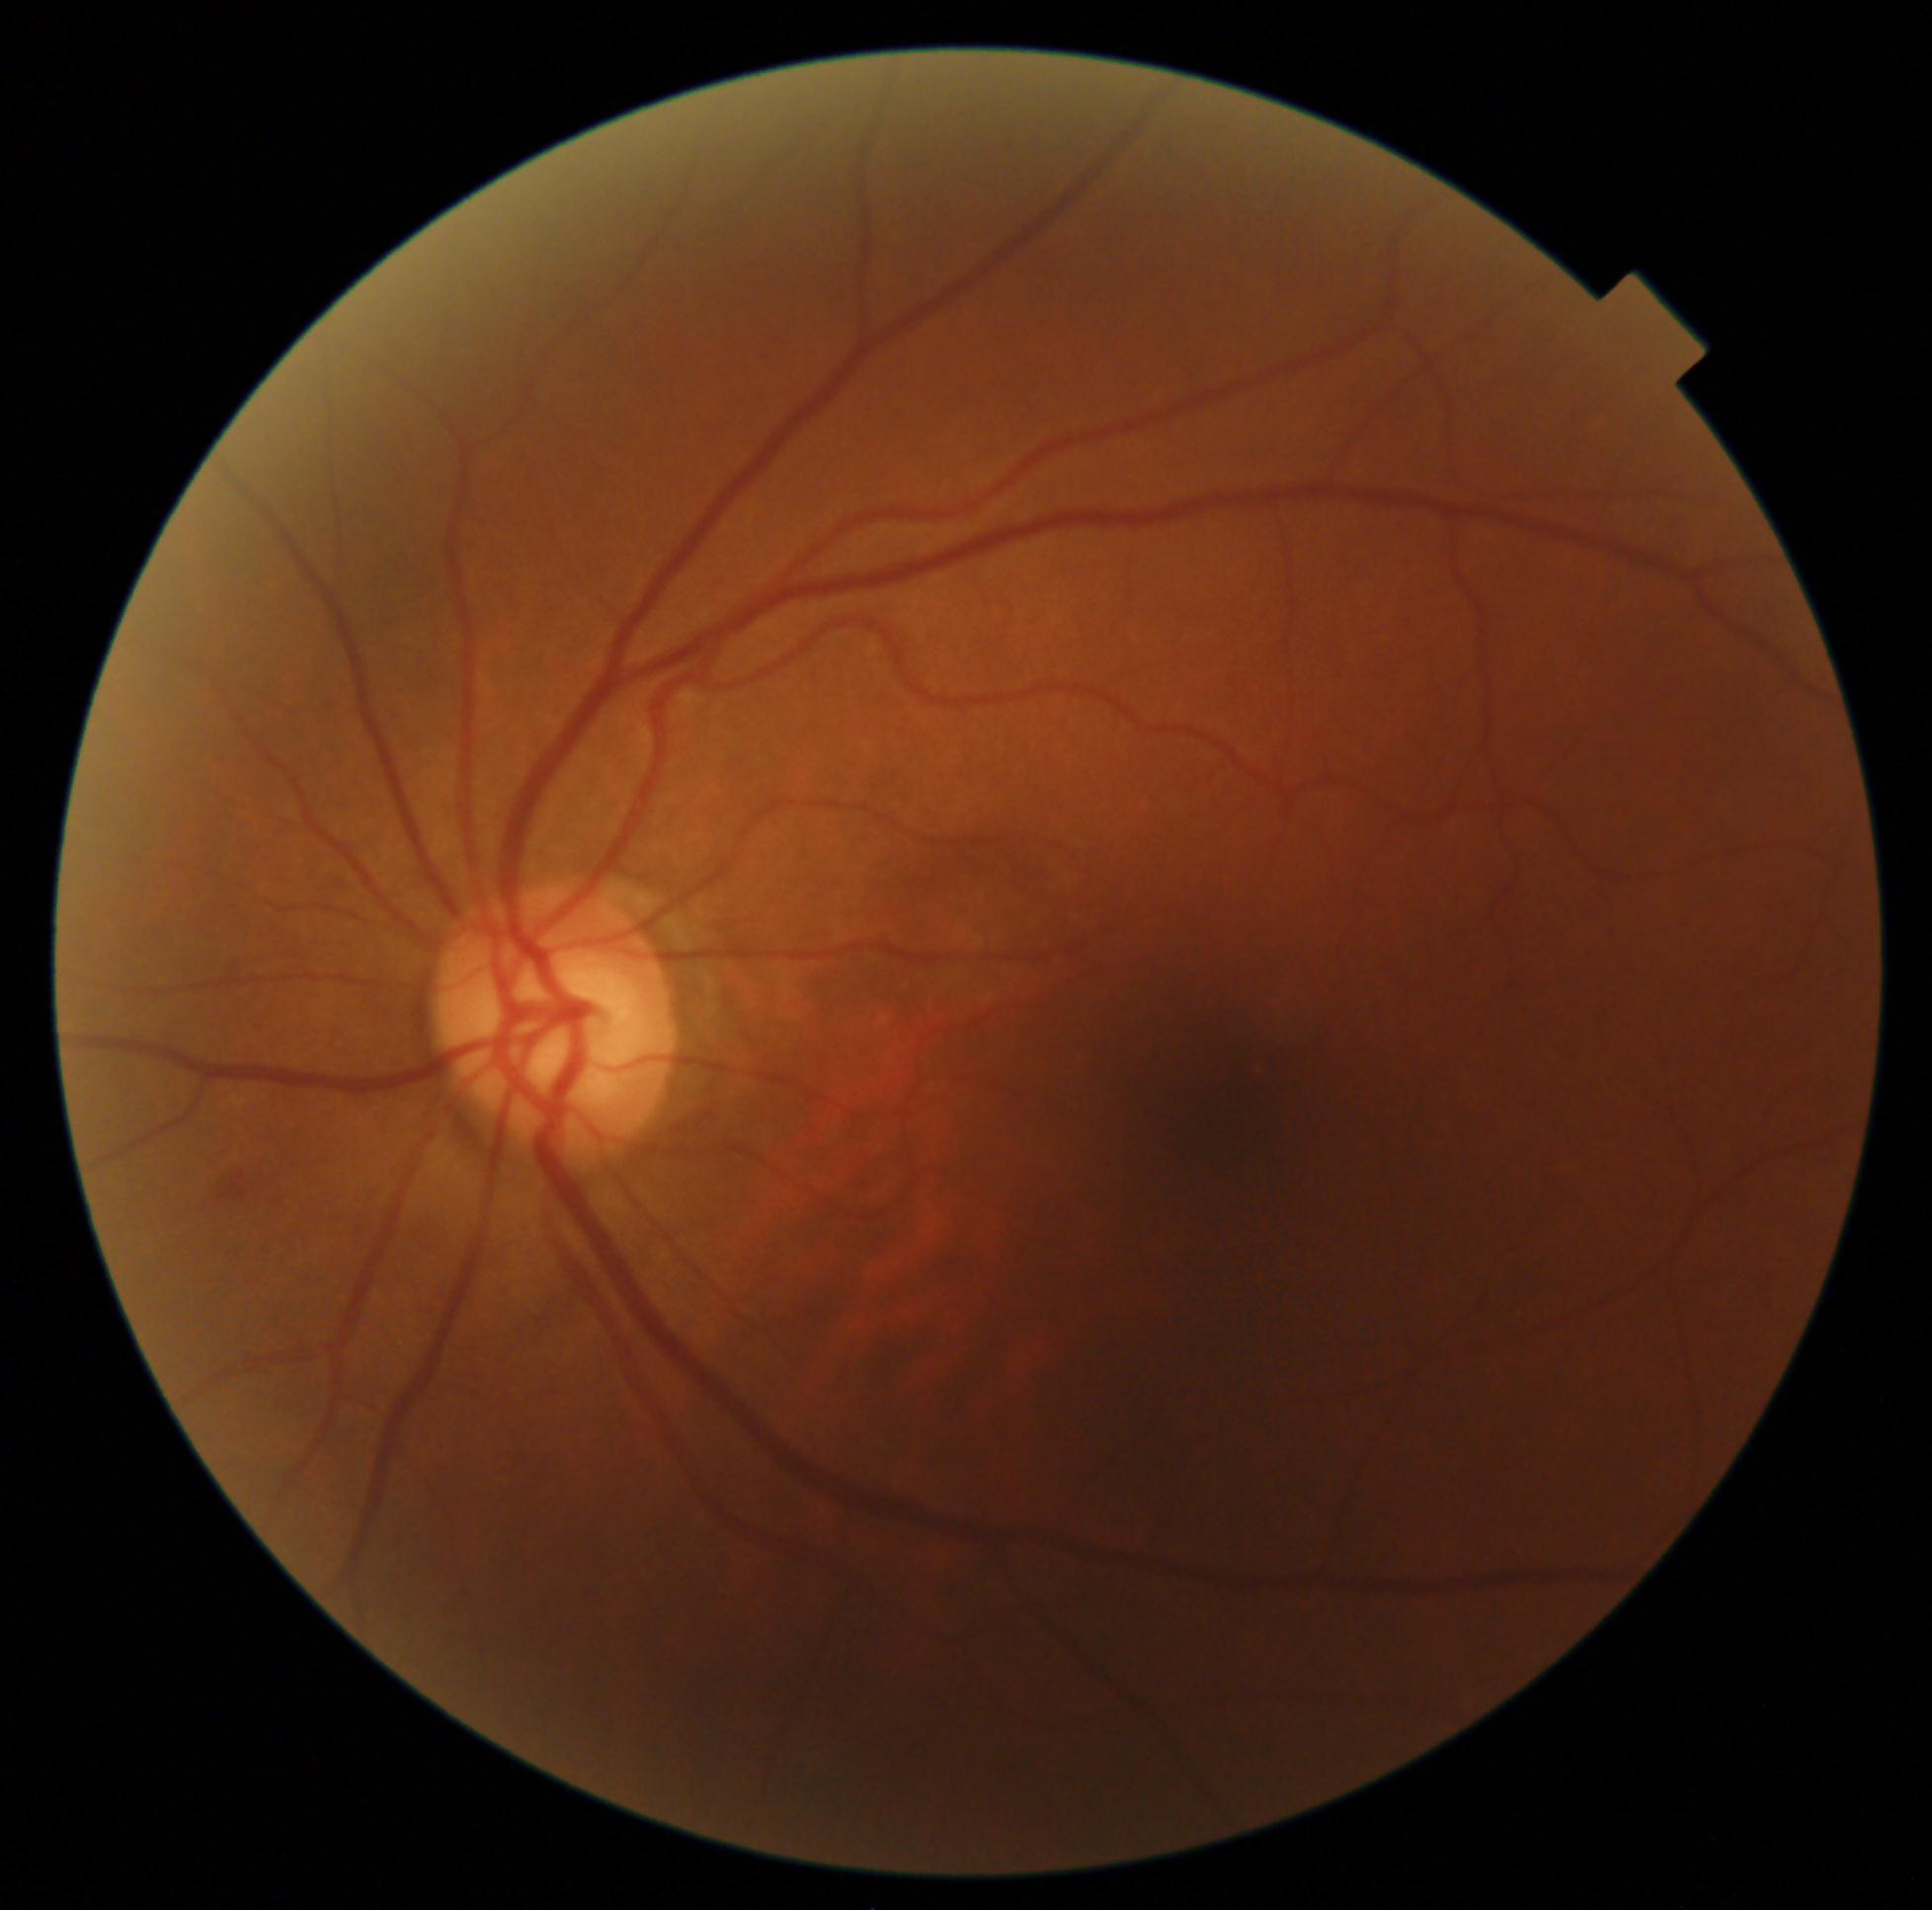
DR: 2/4 — more than just microaneurysms but less than severe NPDR.